Tabletop color fundus camera image, 412 x 310 pixels
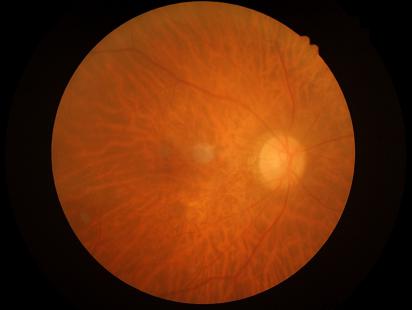
Quality grading: clarity: out of focus, structures indistinct; contrast: wide intensity range, structures distinguishable; illumination: good illumination and color balance; overall: poor, ungradable.